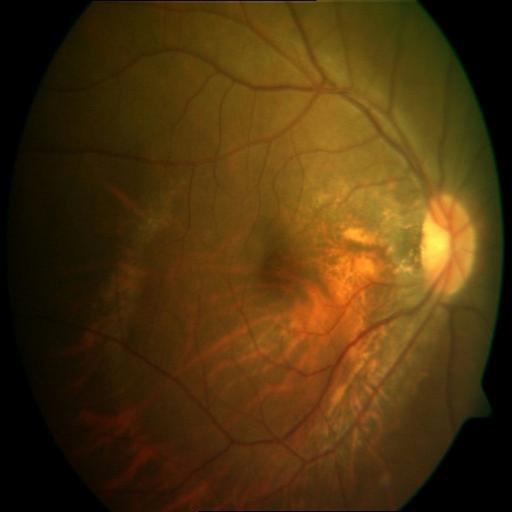
Color fundus photograph showing myopia.